Image size 1240x1240; wide-field contact fundus photograph of an infant; captured with the Phoenix ICON (100° field of view):
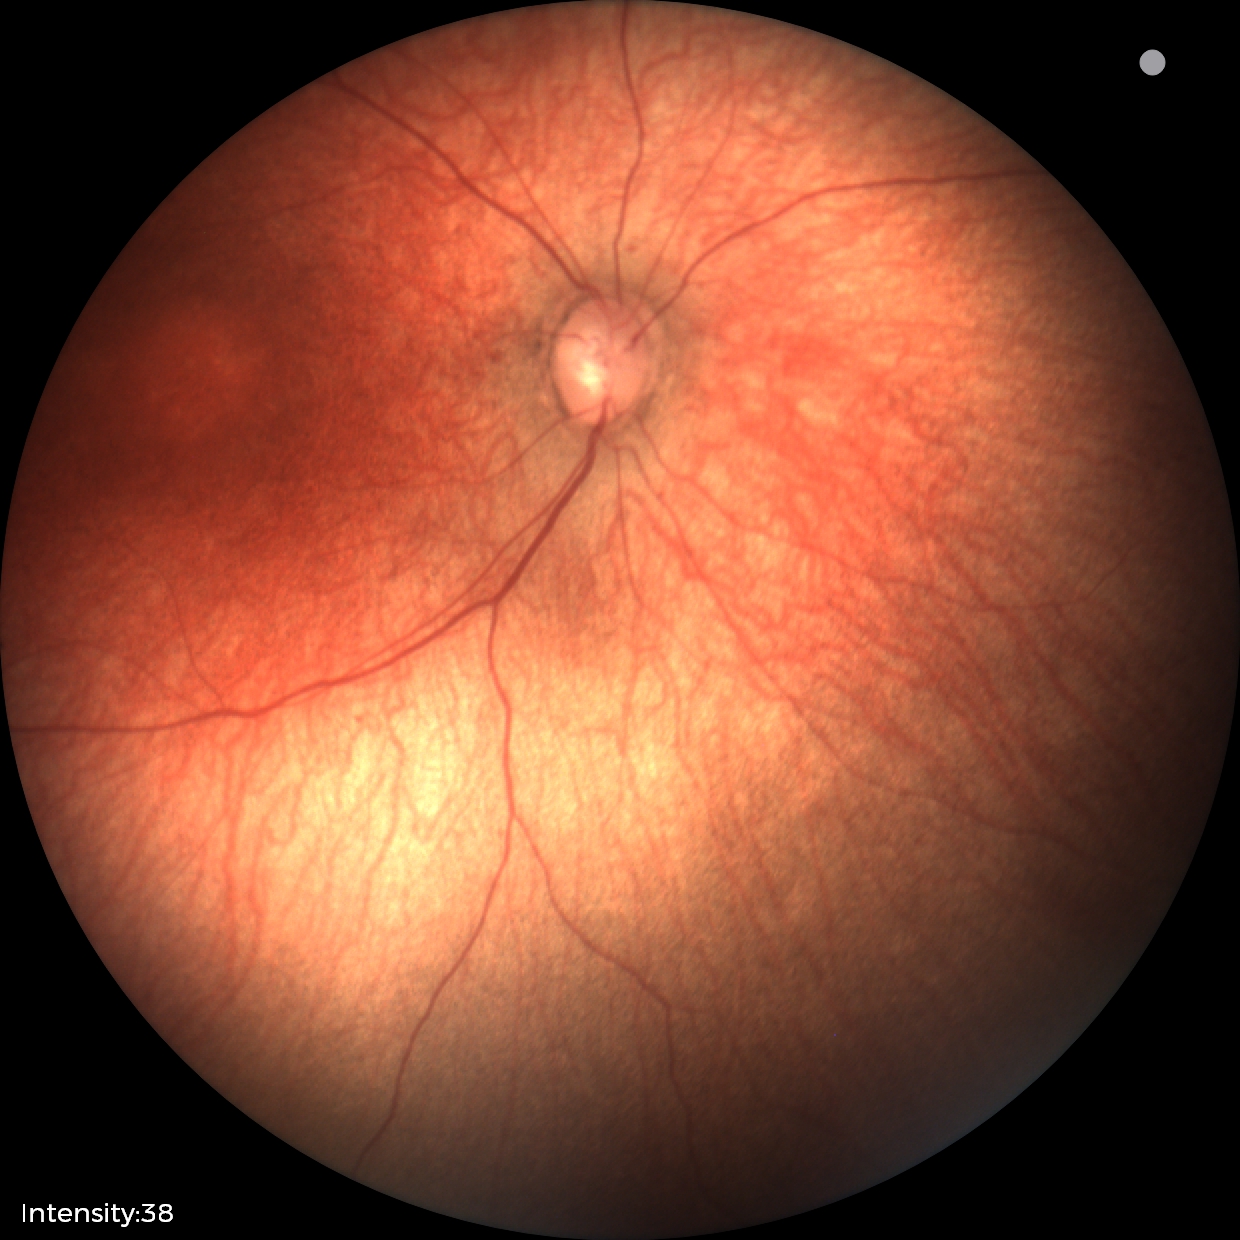

Examination with physiological retinal findings.